Non-mydriatic: 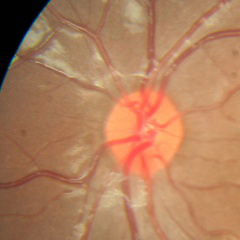

There is evidence of no glaucomatous findings.